45-degree field of view: 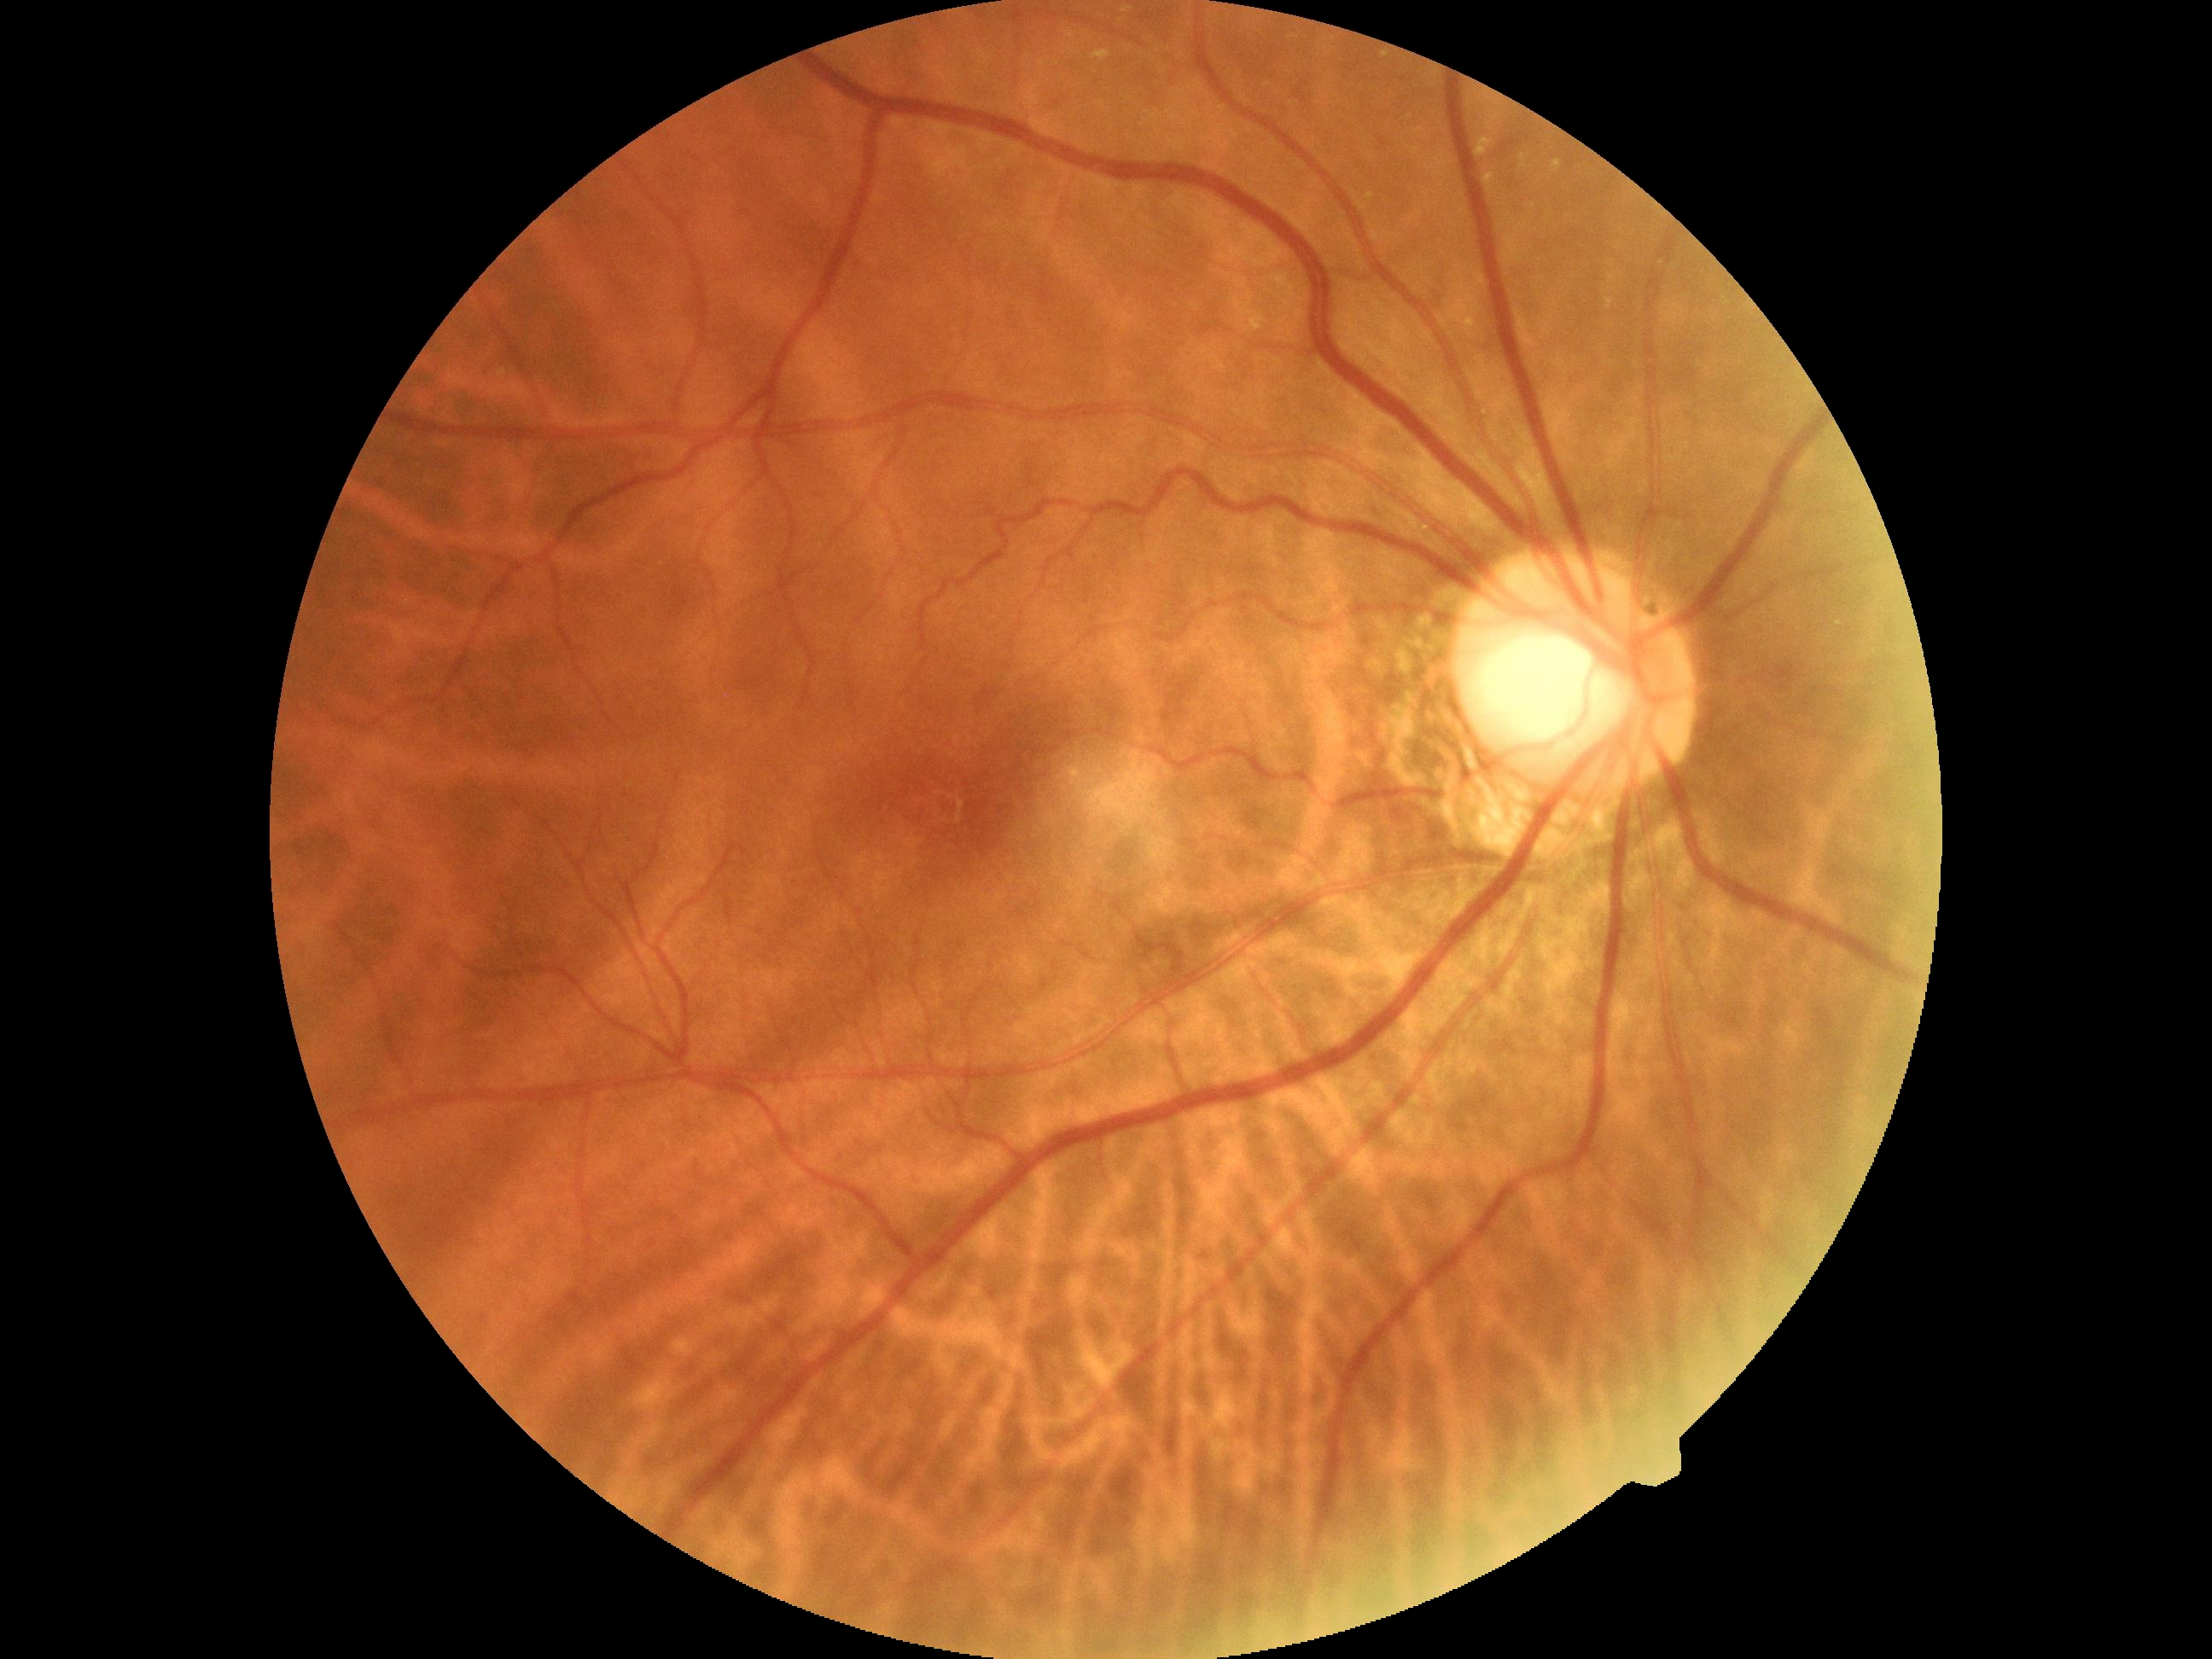

Diabetic retinopathy (DR): grade 0 (no apparent retinopathy) — no visible signs of diabetic retinopathy.
No apparent diabetic retinopathy.